Davis DR grading · 45-degree field of view · 848 by 848 pixels · no pharmacologic dilation · CFP: 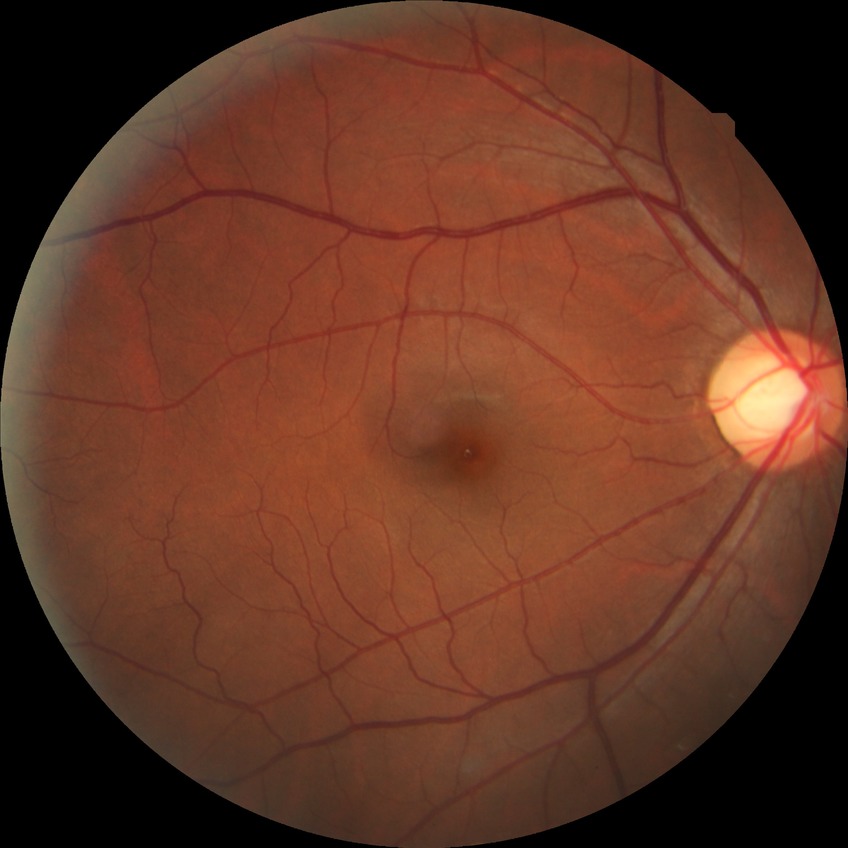

diabetic retinopathy (DR) = no diabetic retinopathy (NDR).